Without pupil dilation · NIDEK AFC-230 · 848 x 848 pixels · 45-degree field of view · retinal fundus photograph · DR severity per modified Davis staging.
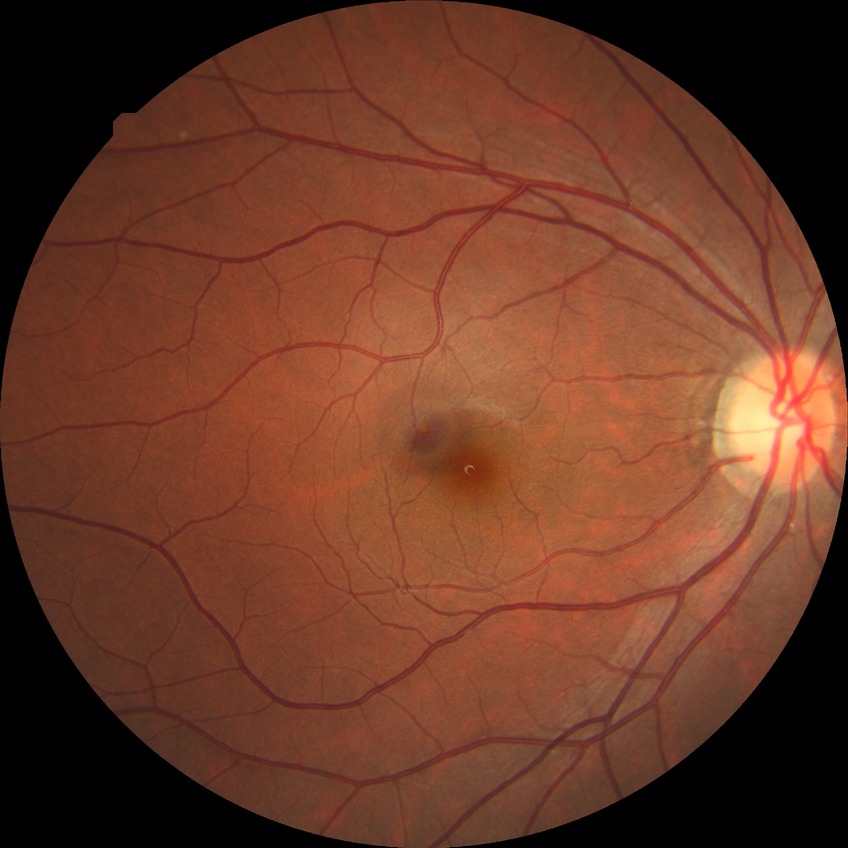

Assessment:
* Davis stage — NDR
* DR impression — negative for DR